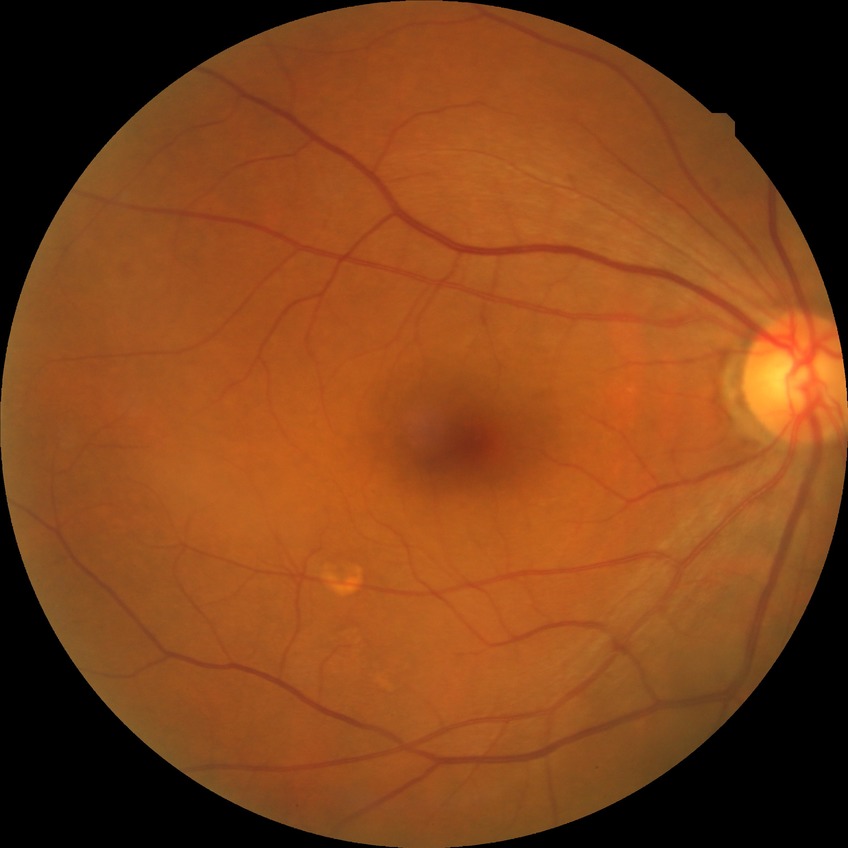

diabetic retinopathy stage: simple diabetic retinopathy.